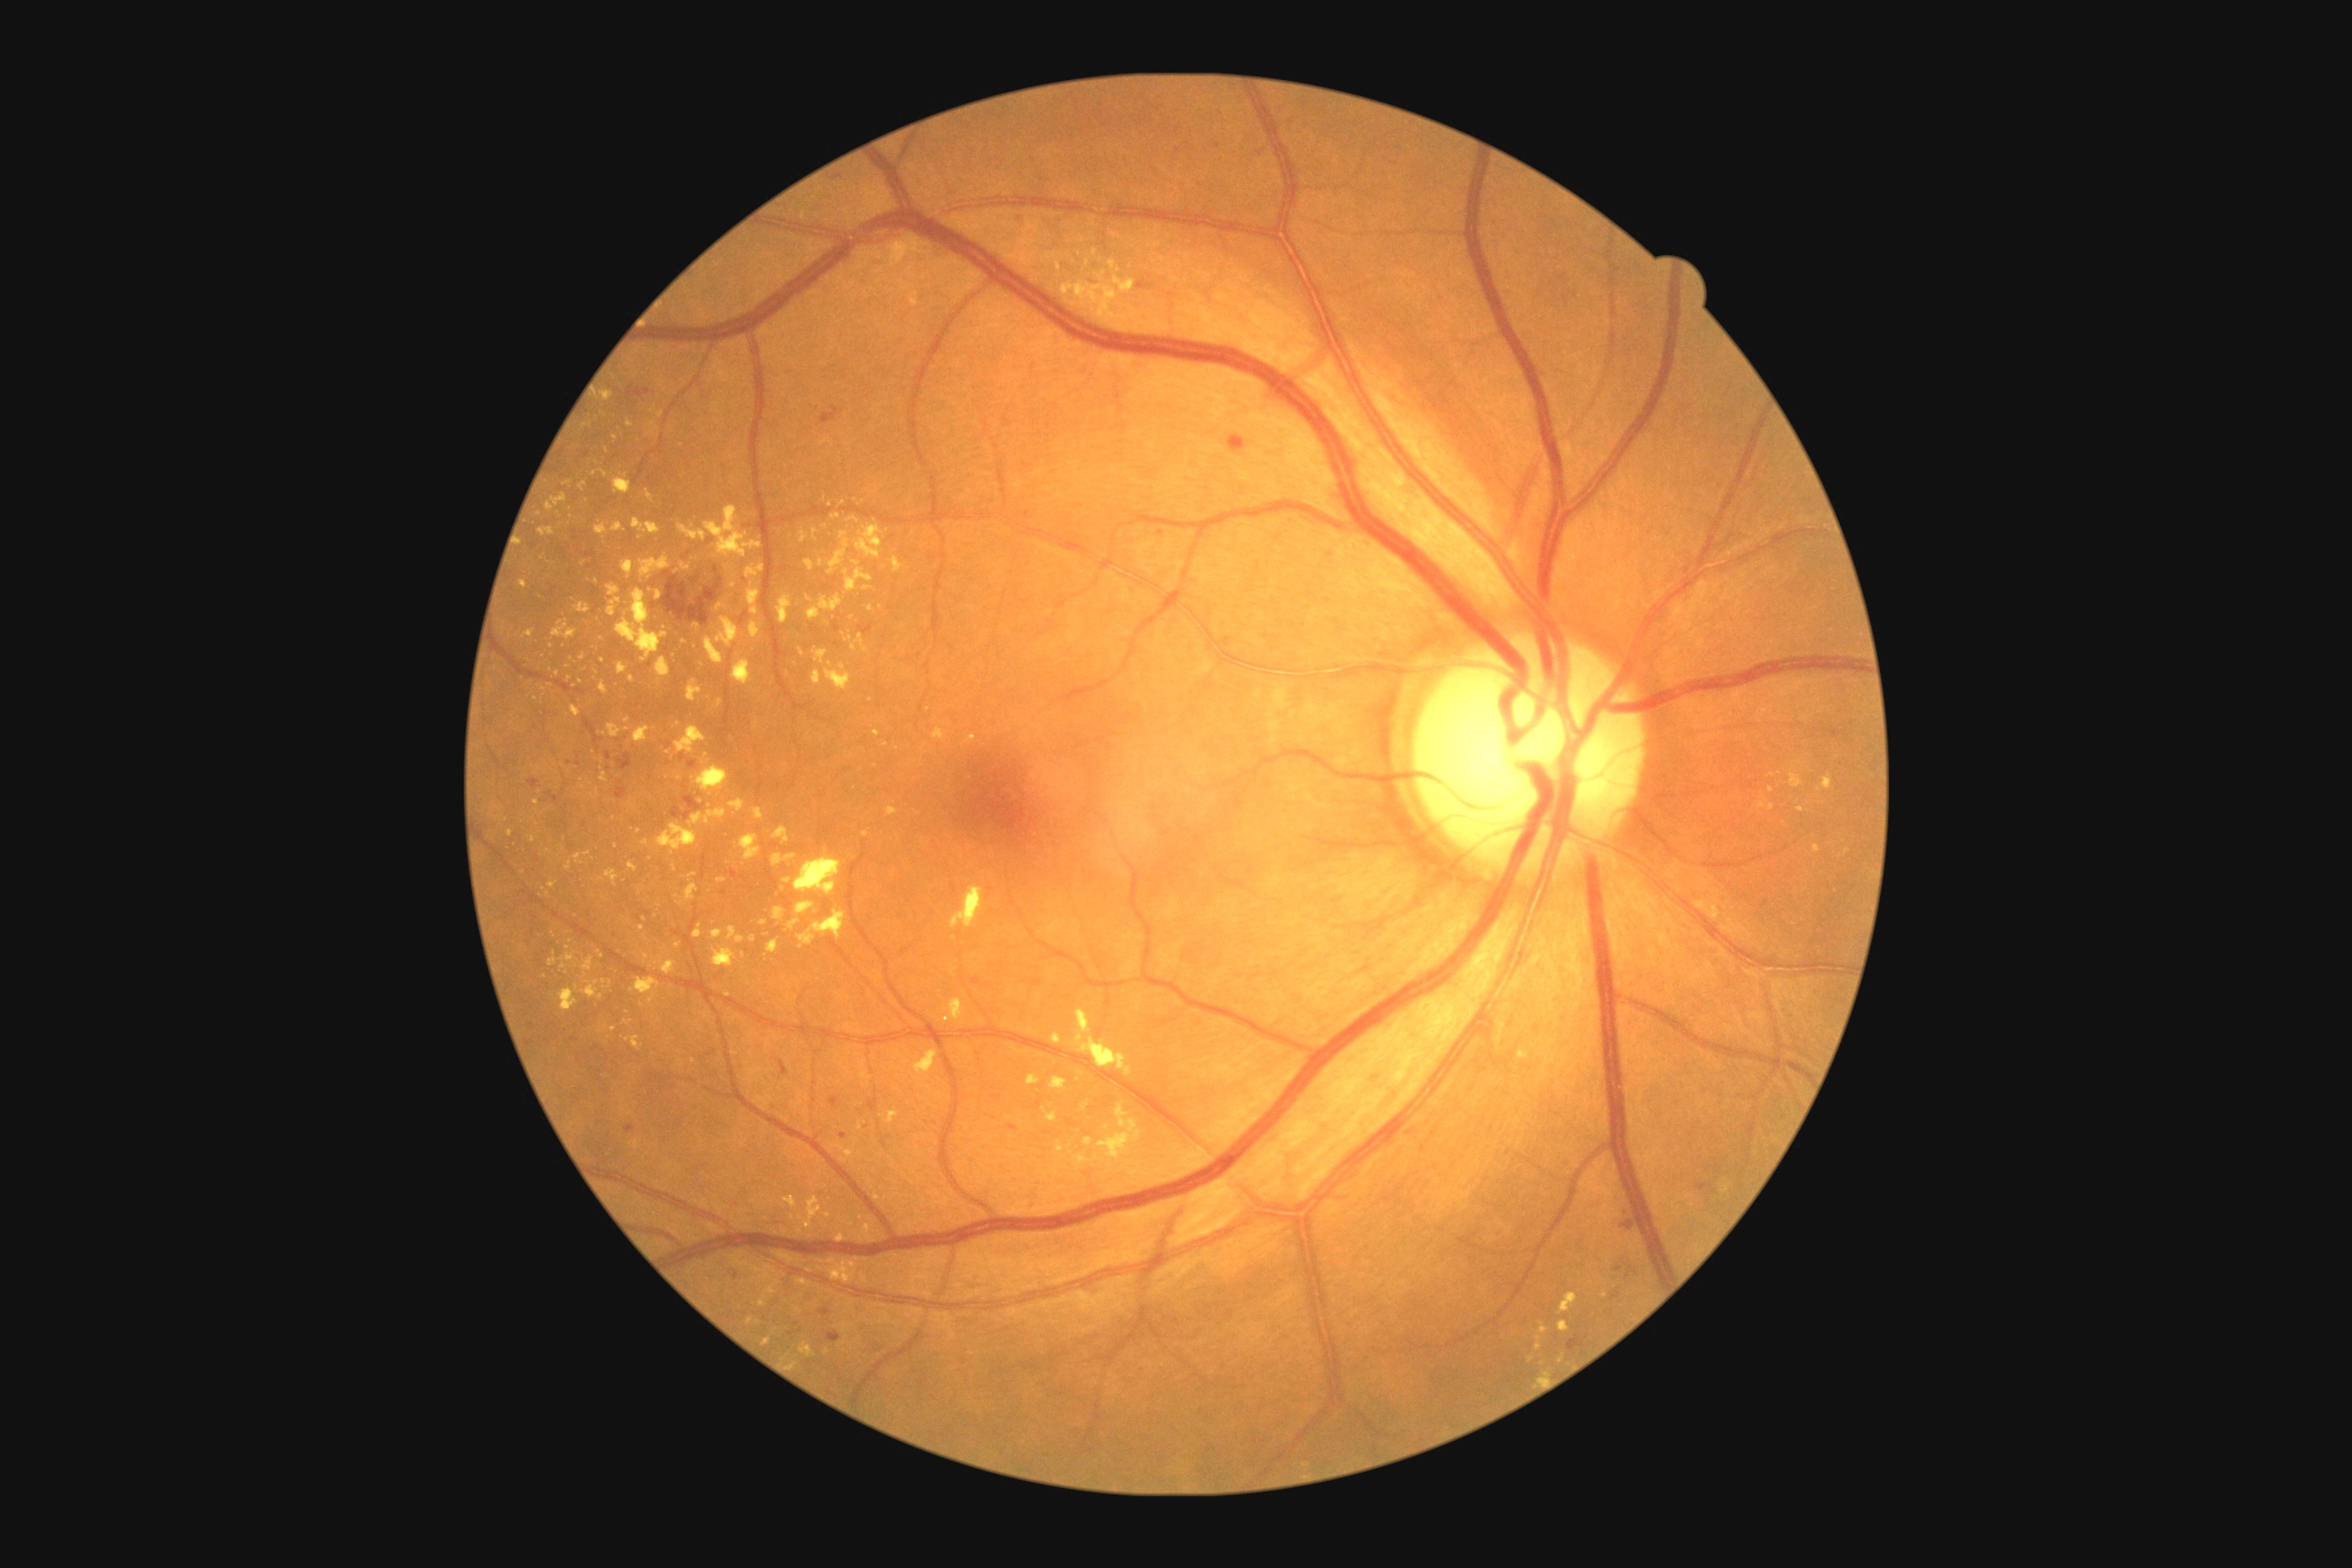 Diabetic retinopathy (DR): 2
Representative lesions:
• microaneurysms (MAs) (more not shown): box(618, 792, 623, 801); box(839, 1133, 847, 1141); box(823, 411, 828, 422); box(643, 389, 651, 393); box(1008, 1124, 1017, 1132); box(730, 870, 738, 879)
• Small MAs near (1160, 533); (569, 763); (682, 758); (579, 765); (1021, 216)
• hard exudates (EXs) (more not shown): box(502, 623, 505, 632); box(640, 554, 671, 580); box(662, 961, 676, 975); box(876, 1304, 887, 1309); box(712, 930, 723, 939); box(1050, 1077, 1068, 1093); box(1050, 1034, 1063, 1046); box(1073, 1010, 1133, 1077); box(1518, 1052, 1529, 1059); box(553, 622, 576, 640); box(812, 671, 821, 685)
• Small EXs near (820, 1262); (1772, 790); (591, 425); (645, 844); (679, 725); (800, 1232); (848, 640); (872, 701)
• hemorrhages (HEs) (more not shown): box(1620, 1220, 1636, 1230); box(779, 1061, 789, 1077); box(819, 1308, 830, 1315); box(672, 796, 703, 819); box(616, 789, 627, 799); box(1019, 215, 1026, 230); box(529, 779, 540, 789); box(1696, 1184, 1714, 1191); box(1228, 435, 1246, 453); box(707, 1050, 716, 1057); box(618, 754, 632, 770)
• Small HEs near (668, 574); (717, 570)